Fundus photo. 45° FOV. 2352 x 1568 pixels:
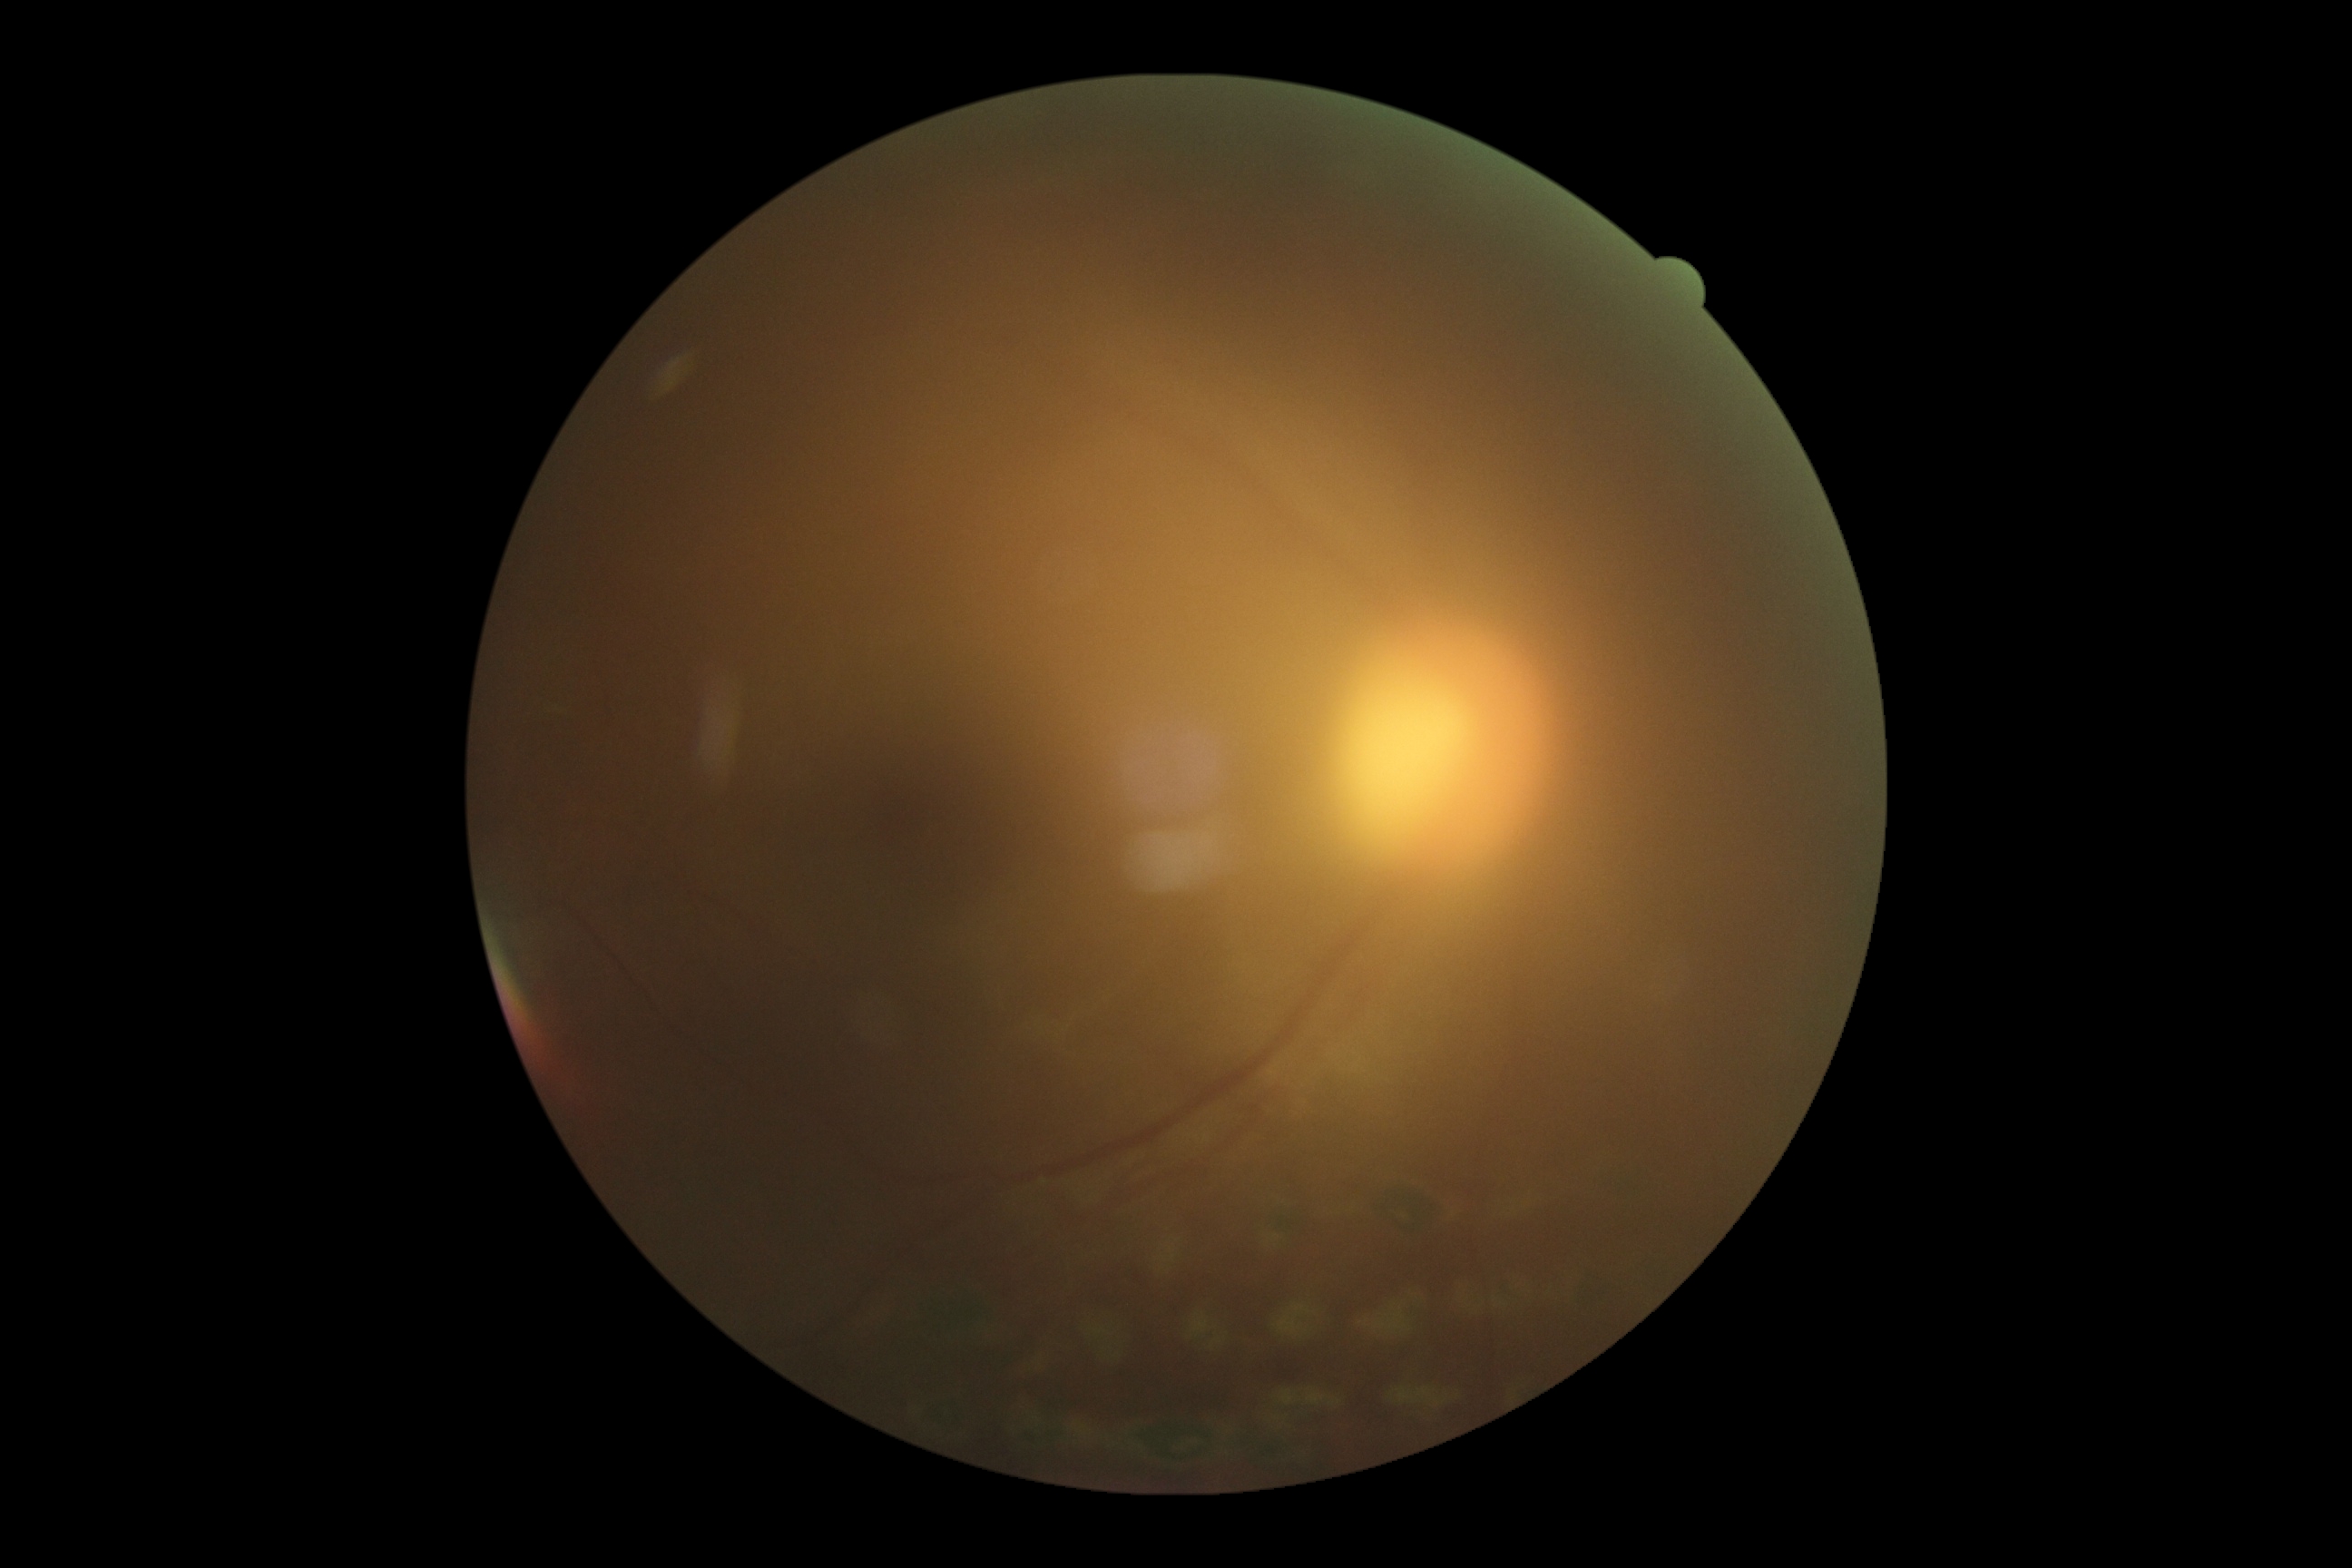 Findings:
- diabetic retinopathy (DR) — grade 0 (no apparent retinopathy)